CFP · 45° FOV: 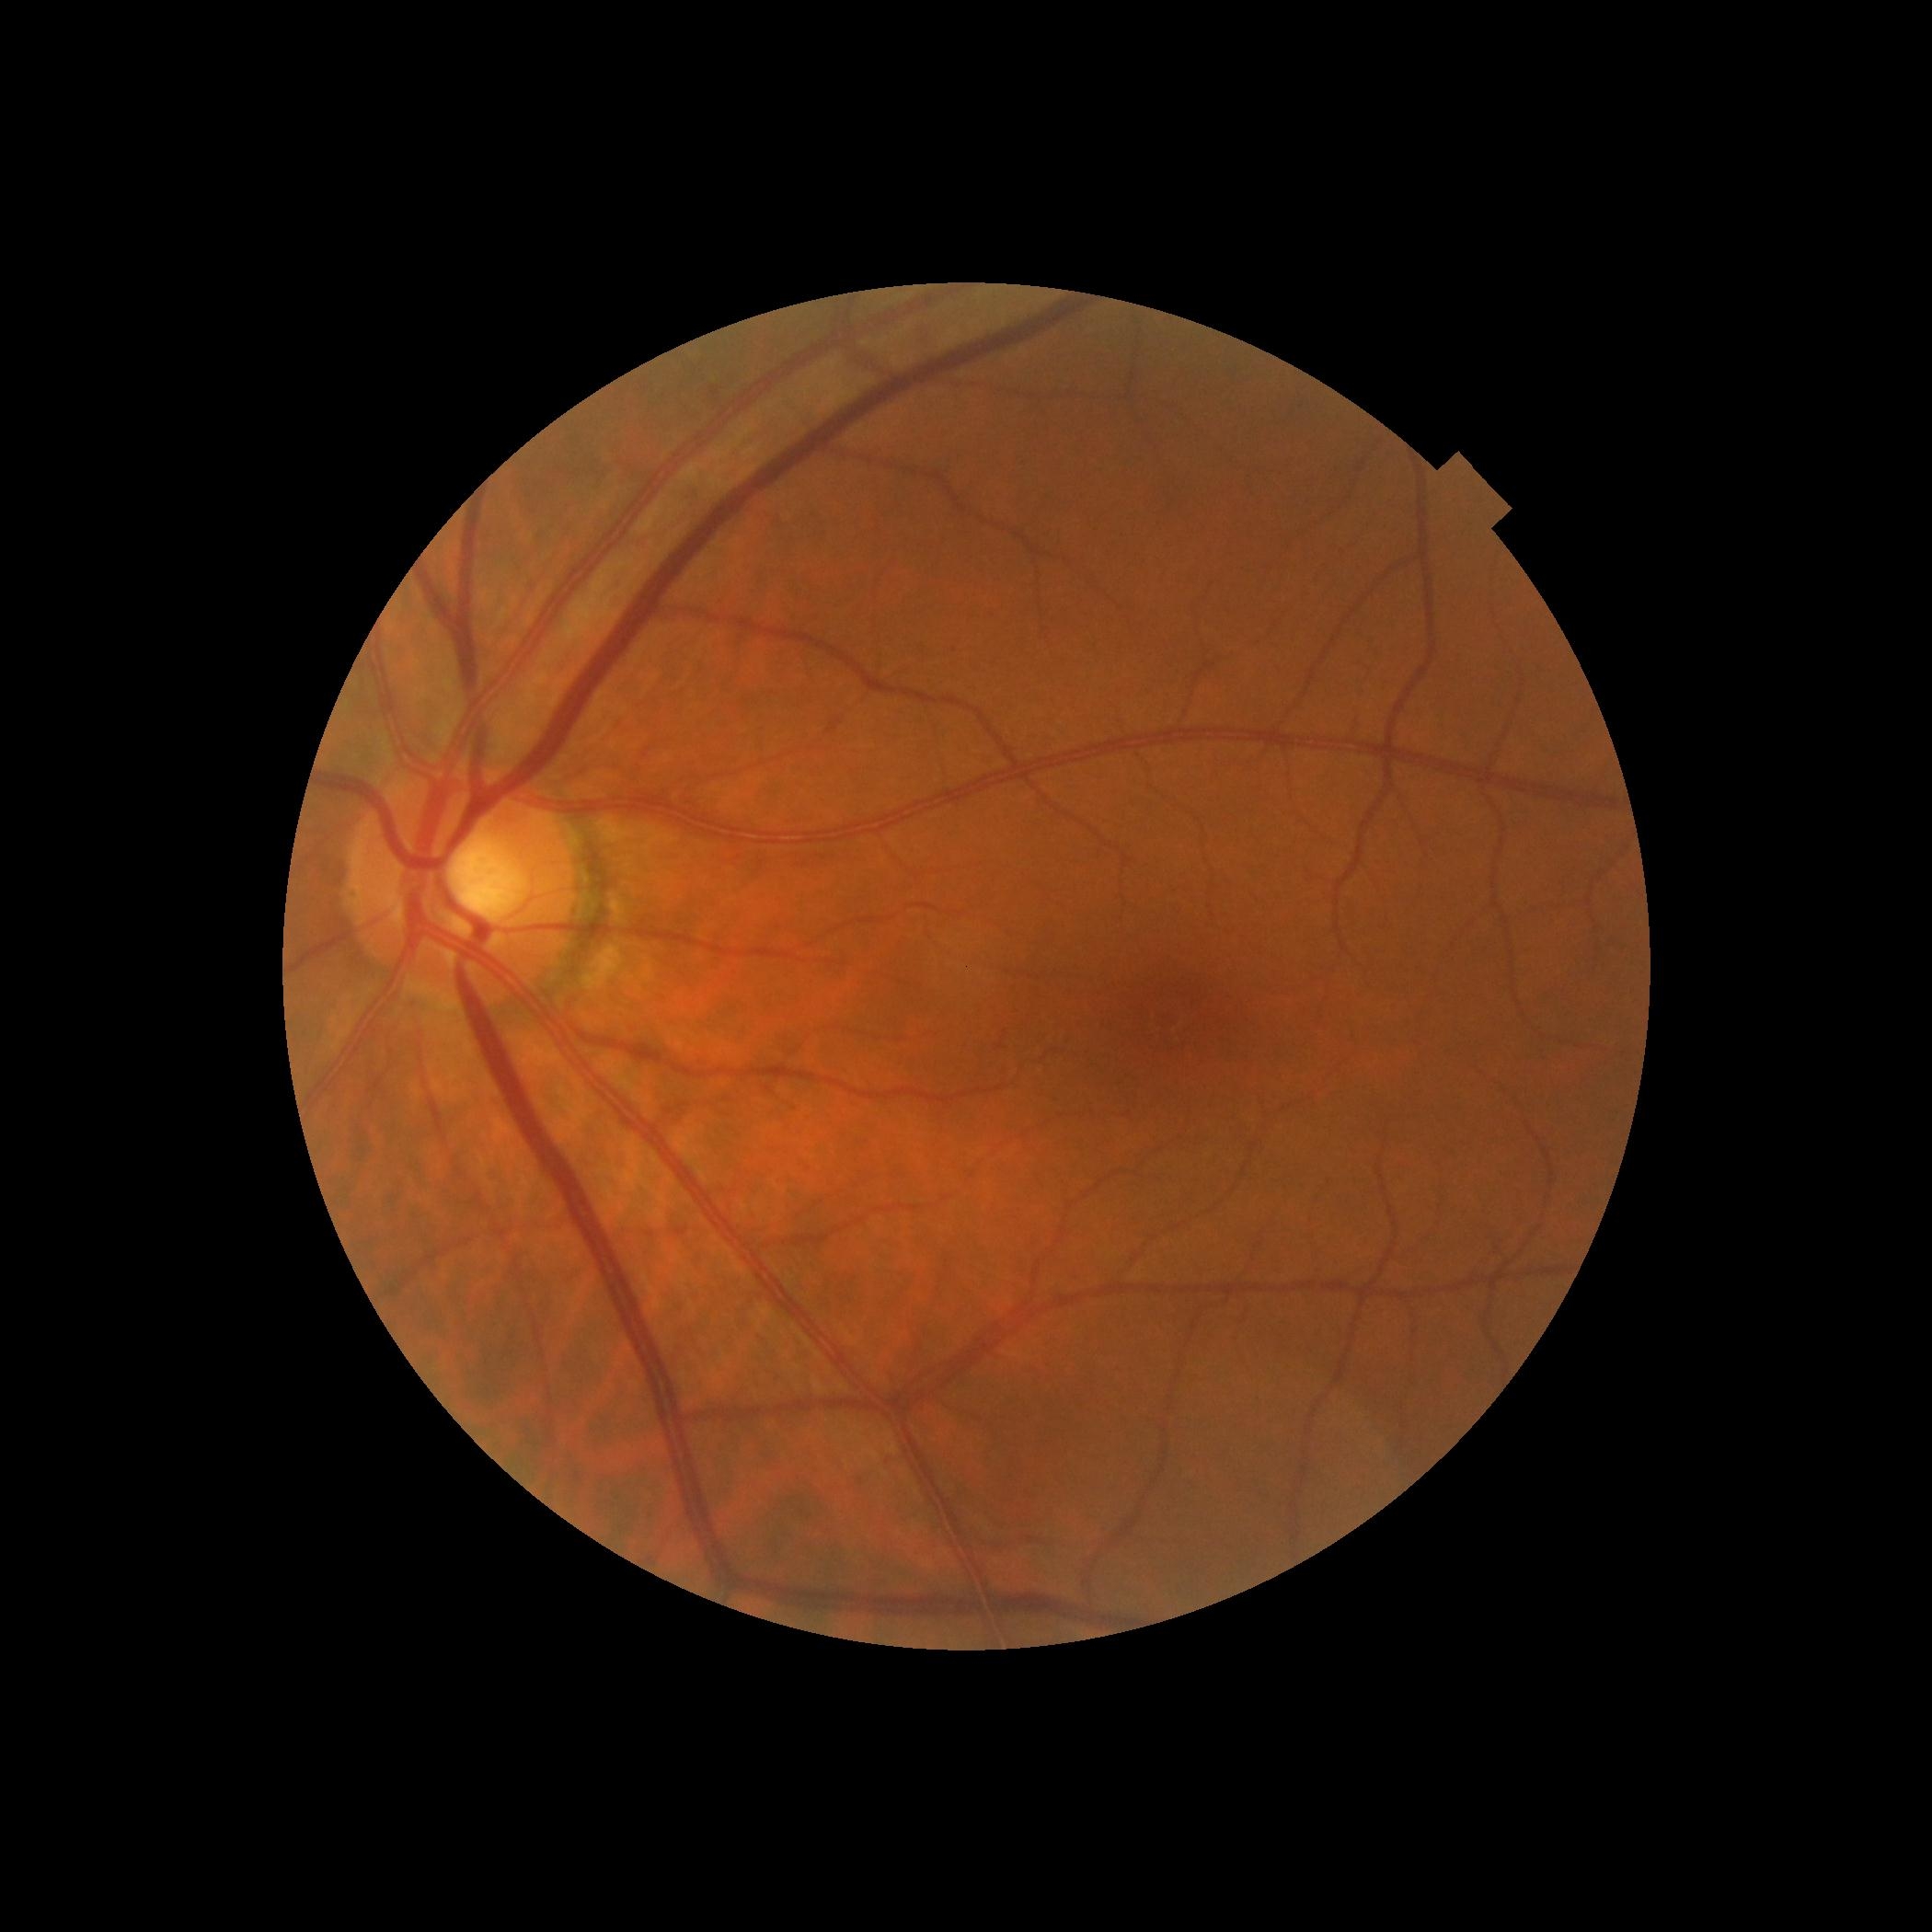
DR grade is no apparent retinopathy (0). No DR findings.